Pediatric wide-field fundus photograph
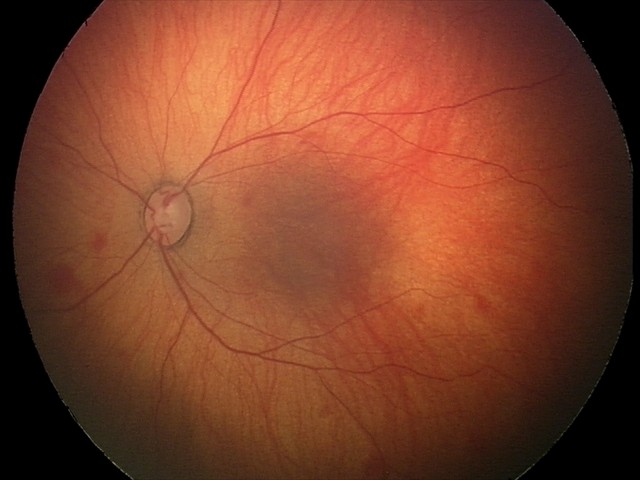

Series diagnosed as retinal hemorrhages.